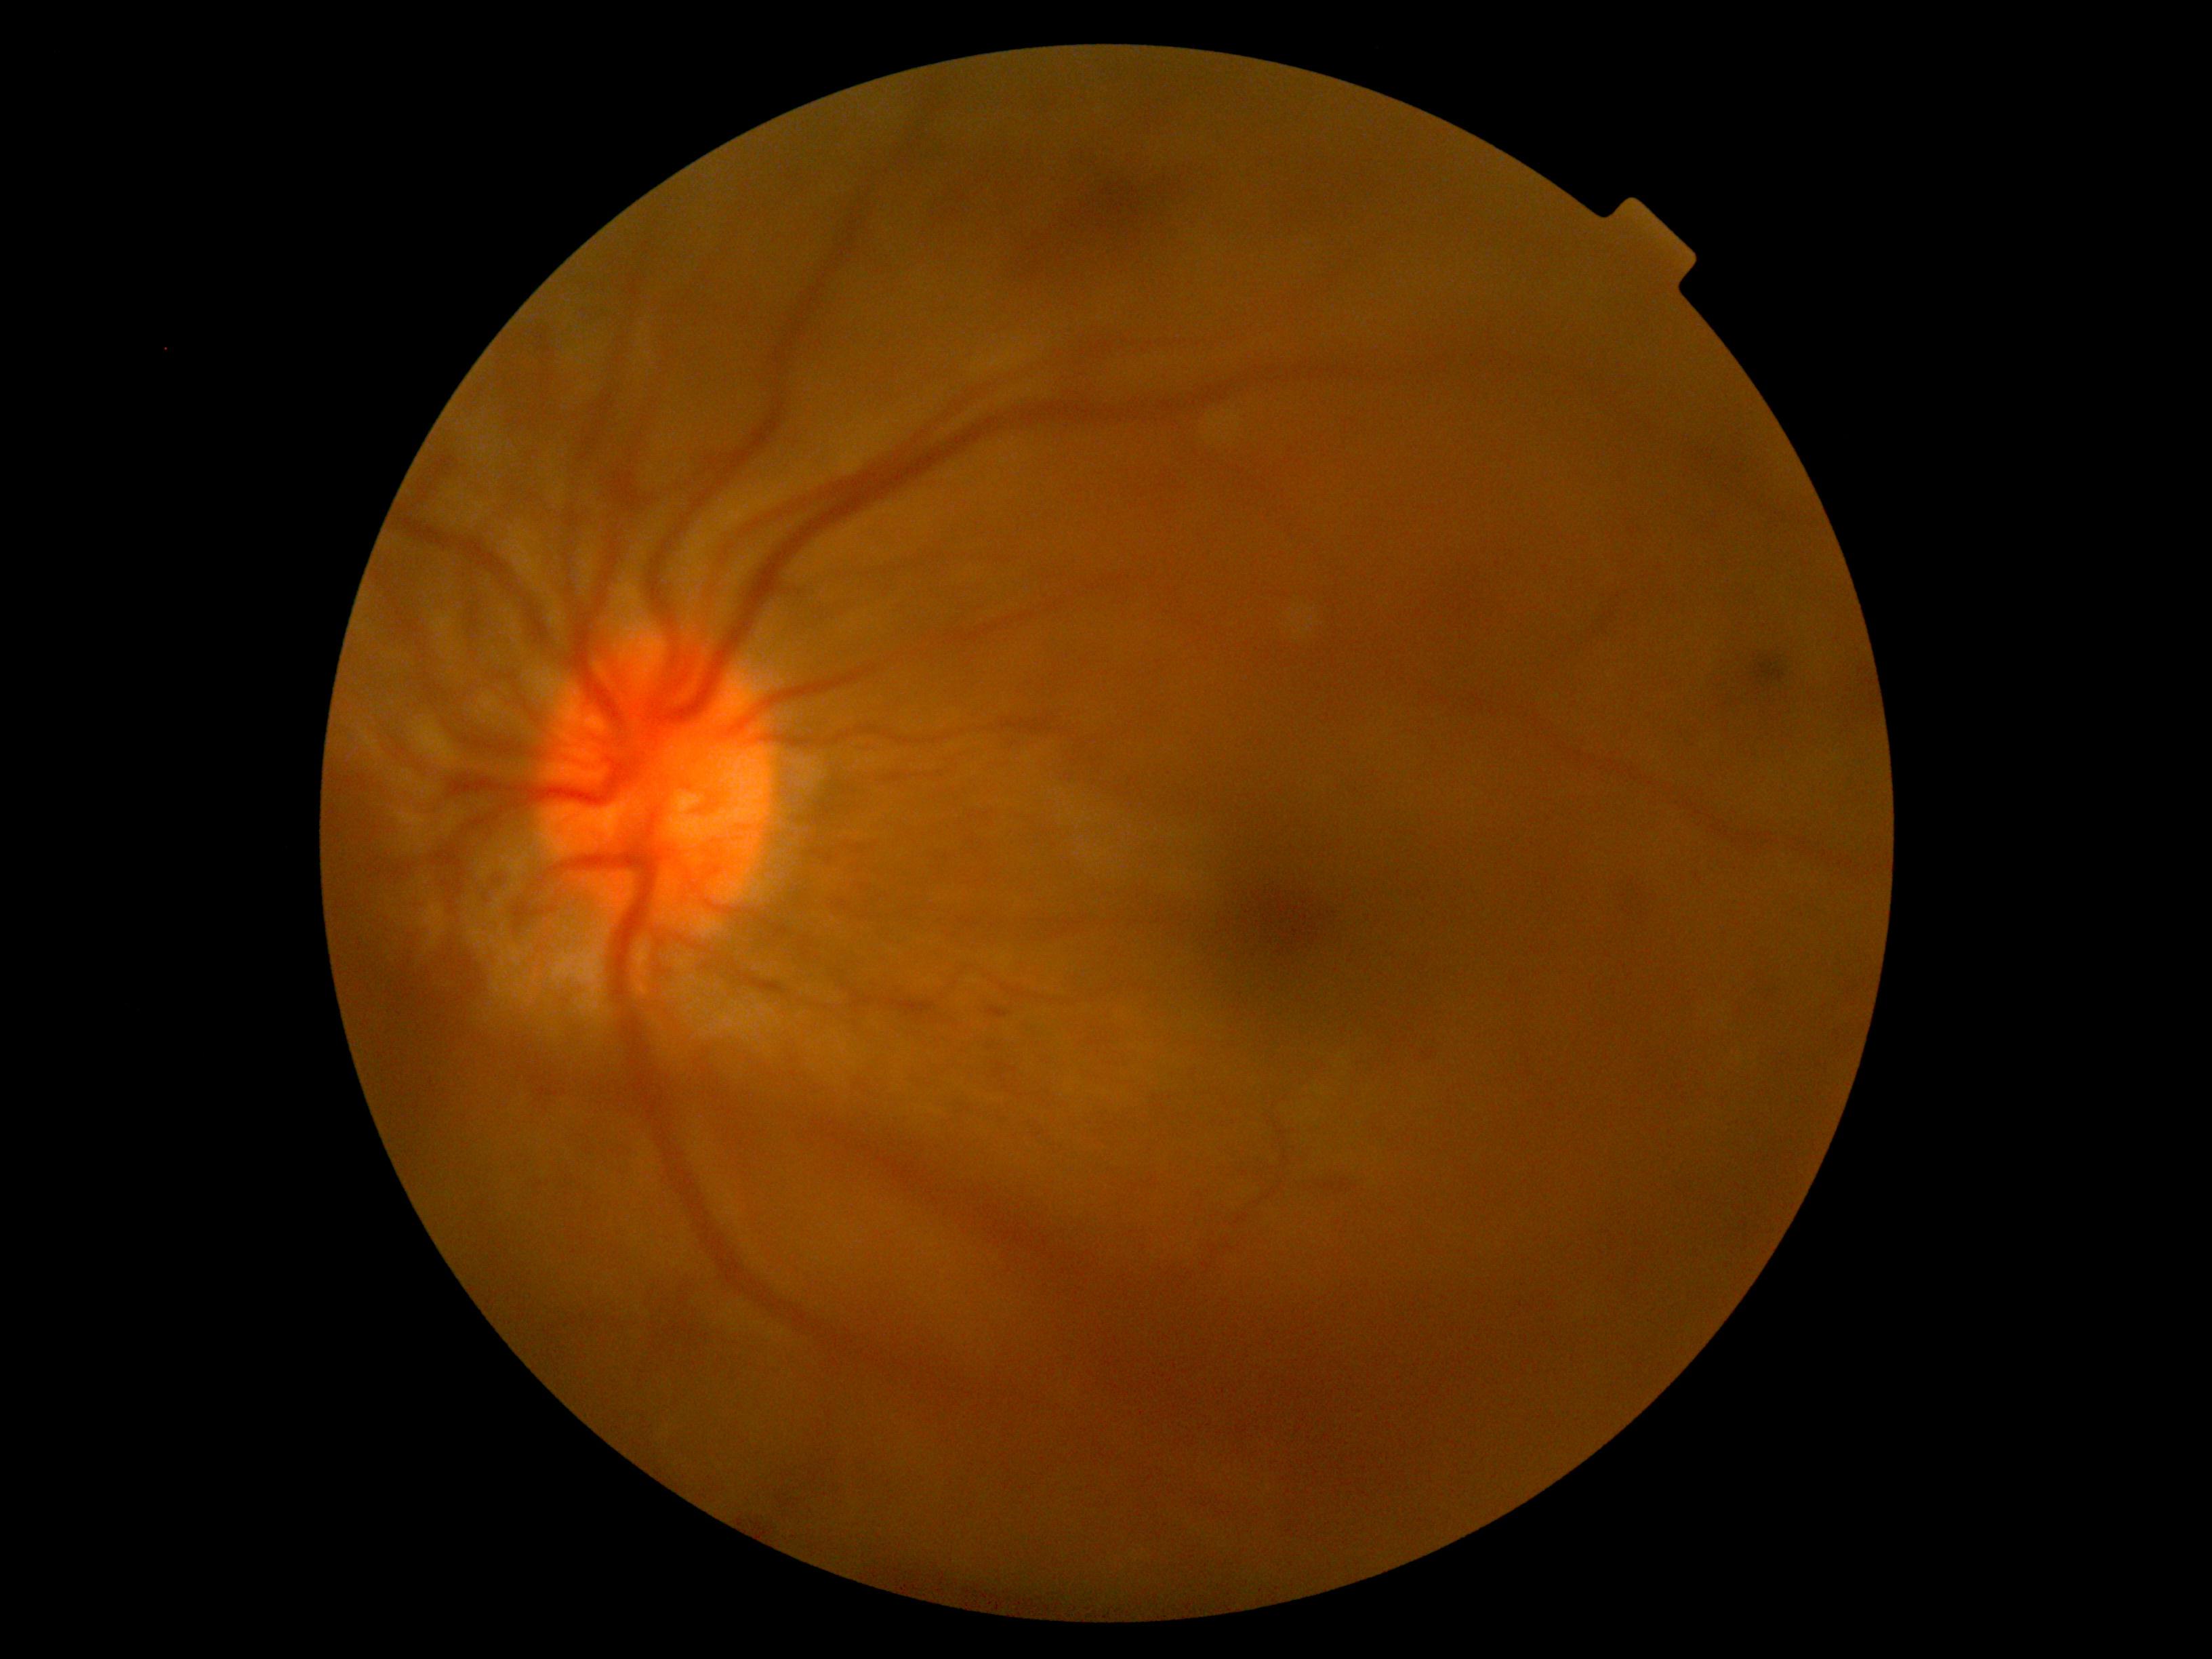

Disease class: proliferative diabetic retinopathy. DR grade is 4 — neovascularization and/or vitreous/pre-retinal hemorrhage.